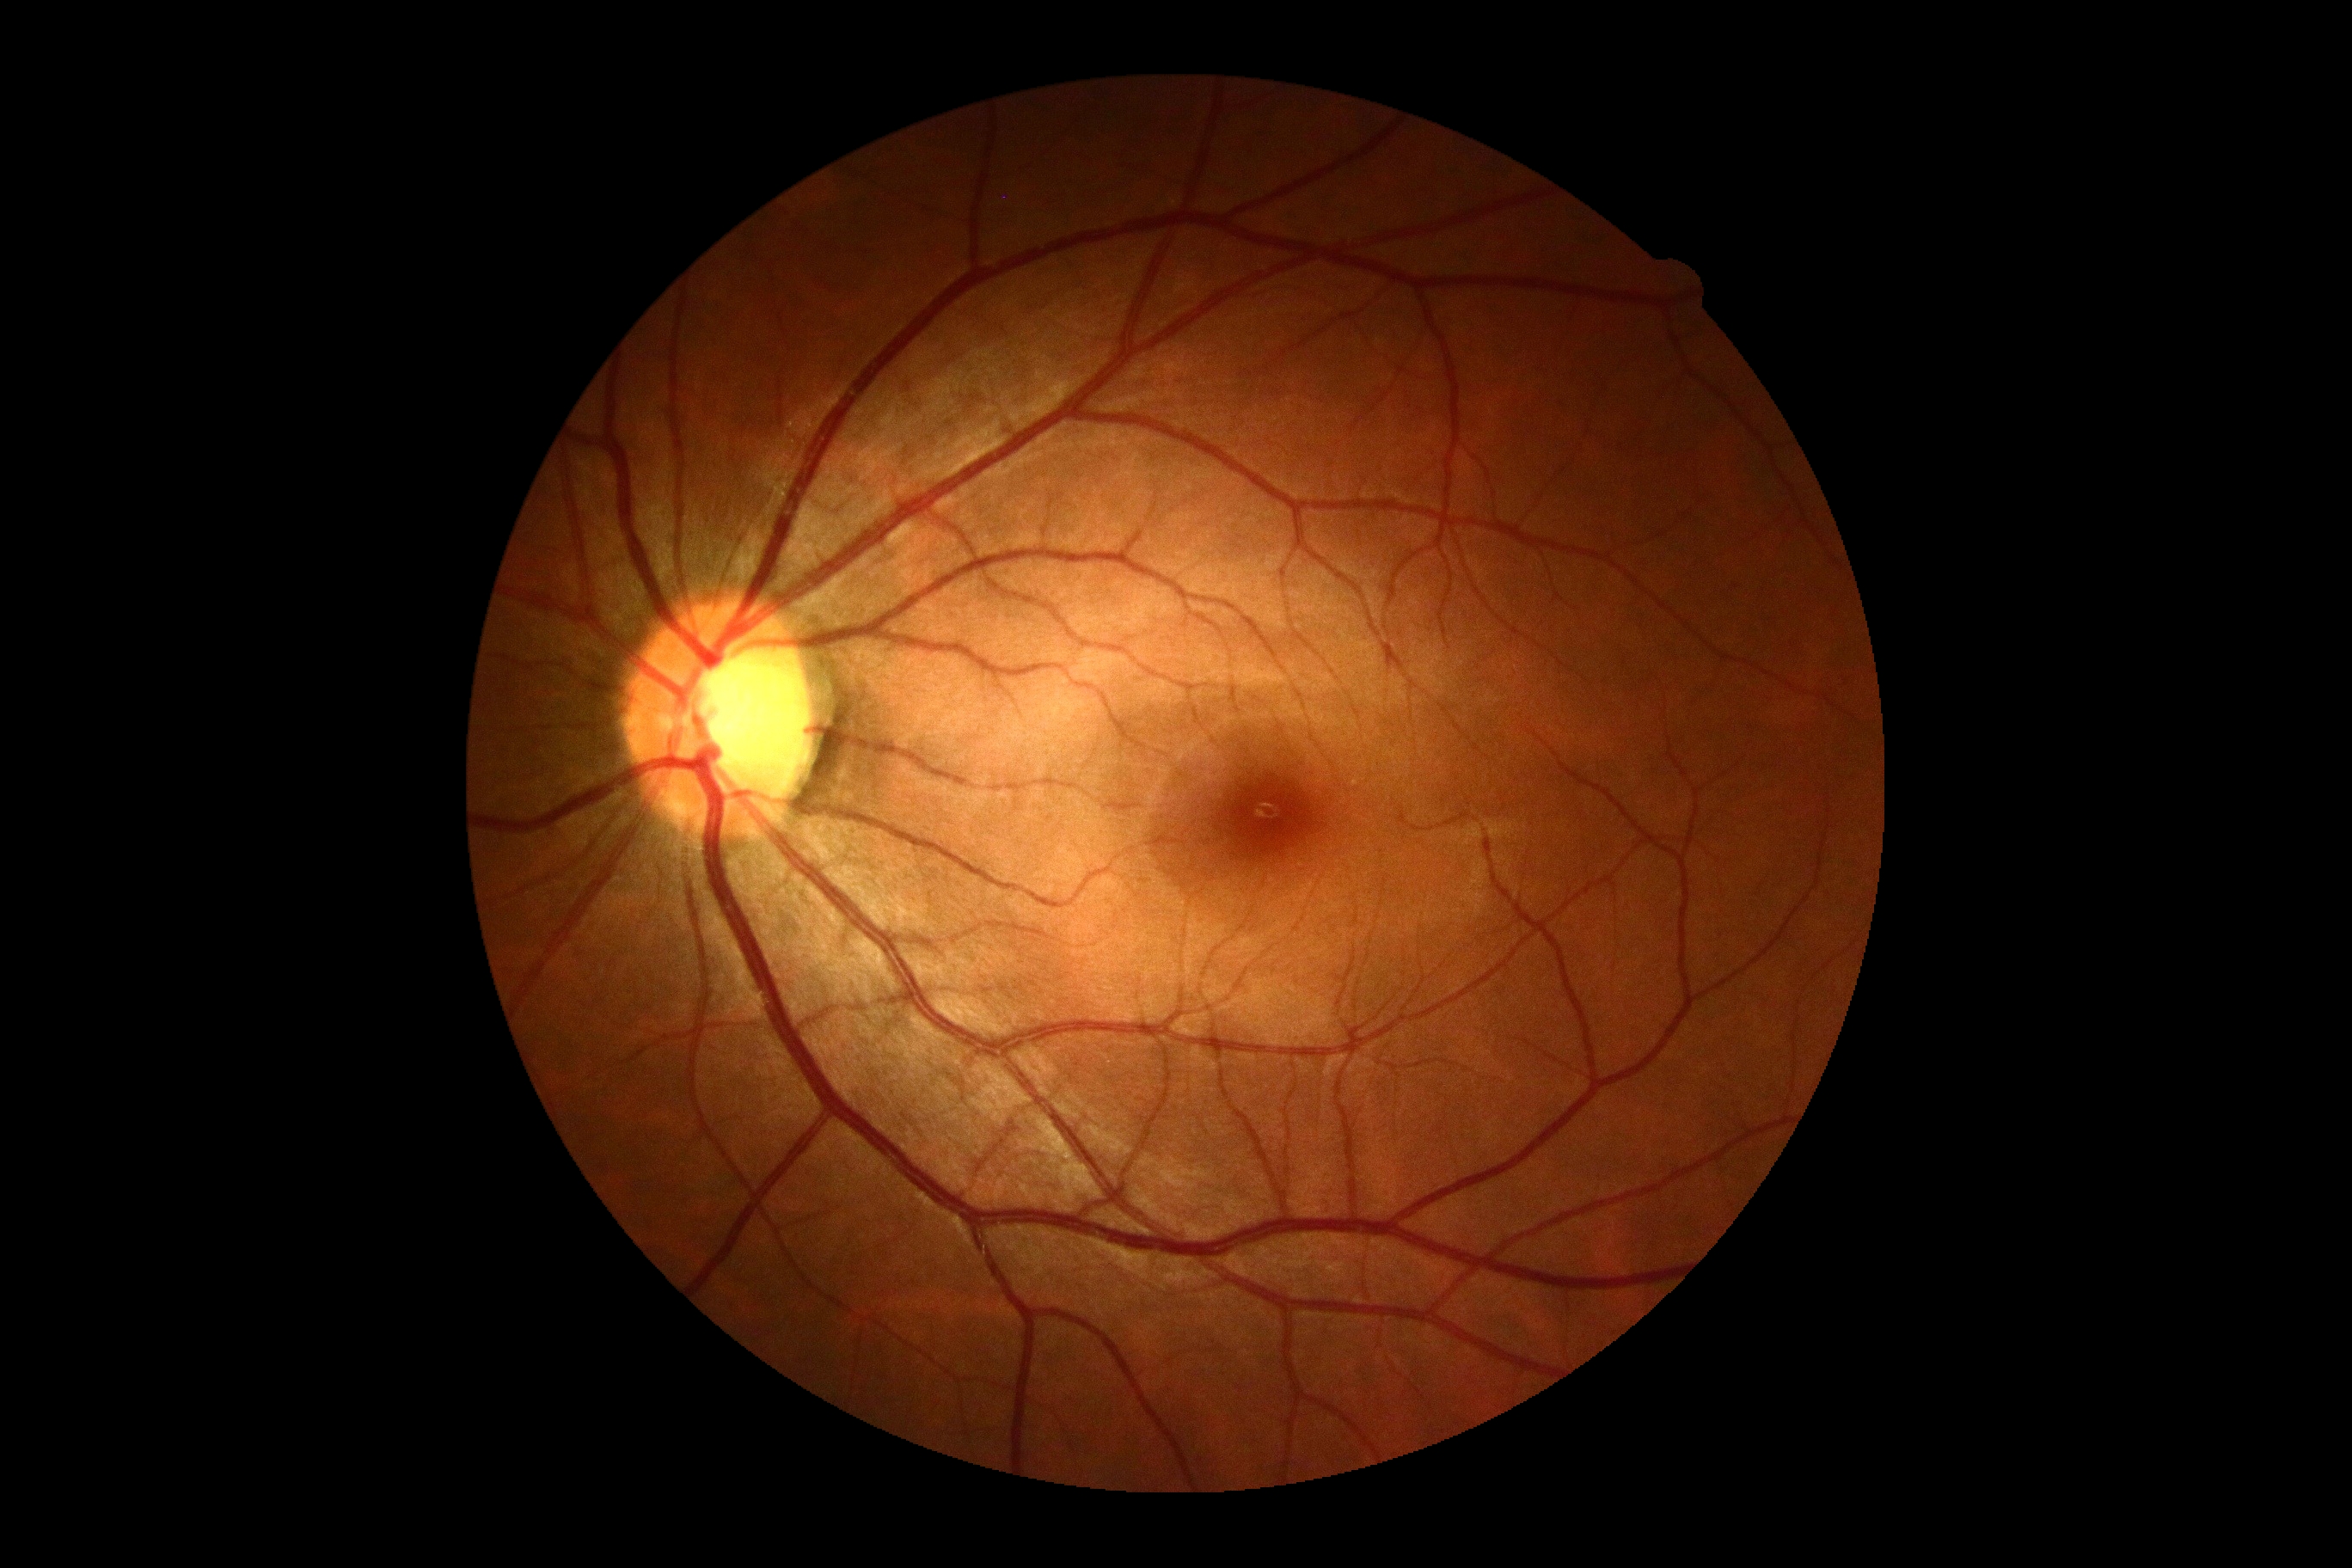
Diabetic retinopathy grade is 0 (no apparent retinopathy).